45 degree fundus photograph · diabetic retinopathy graded by the modified Davis classification · 848x848: 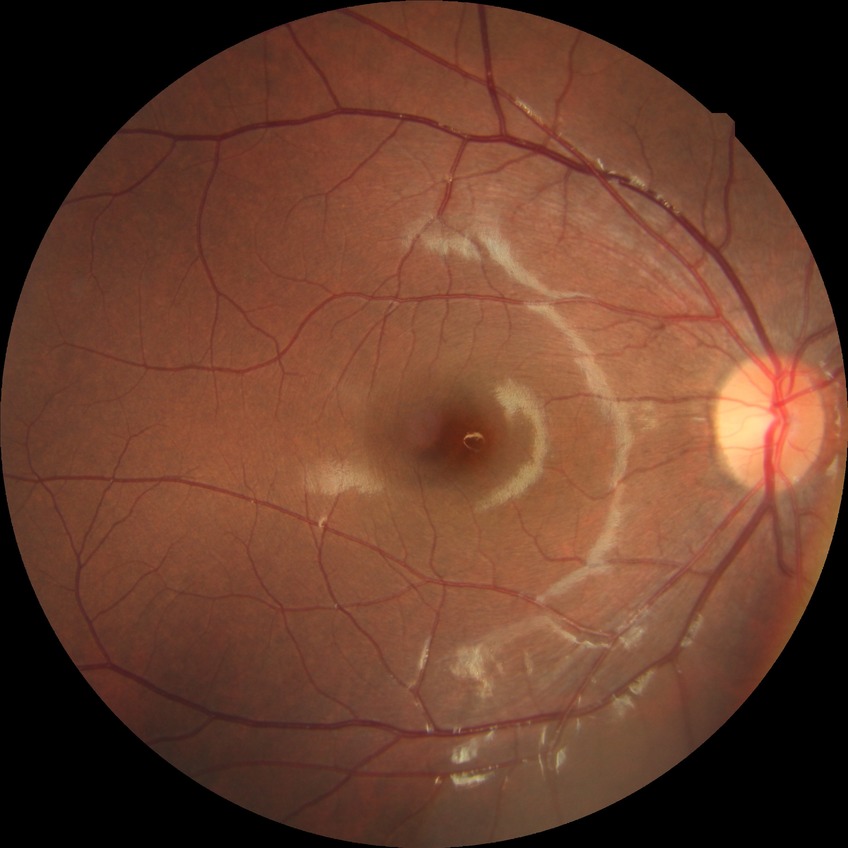
Assessment:
- modified Davis classification — no diabetic retinopathy